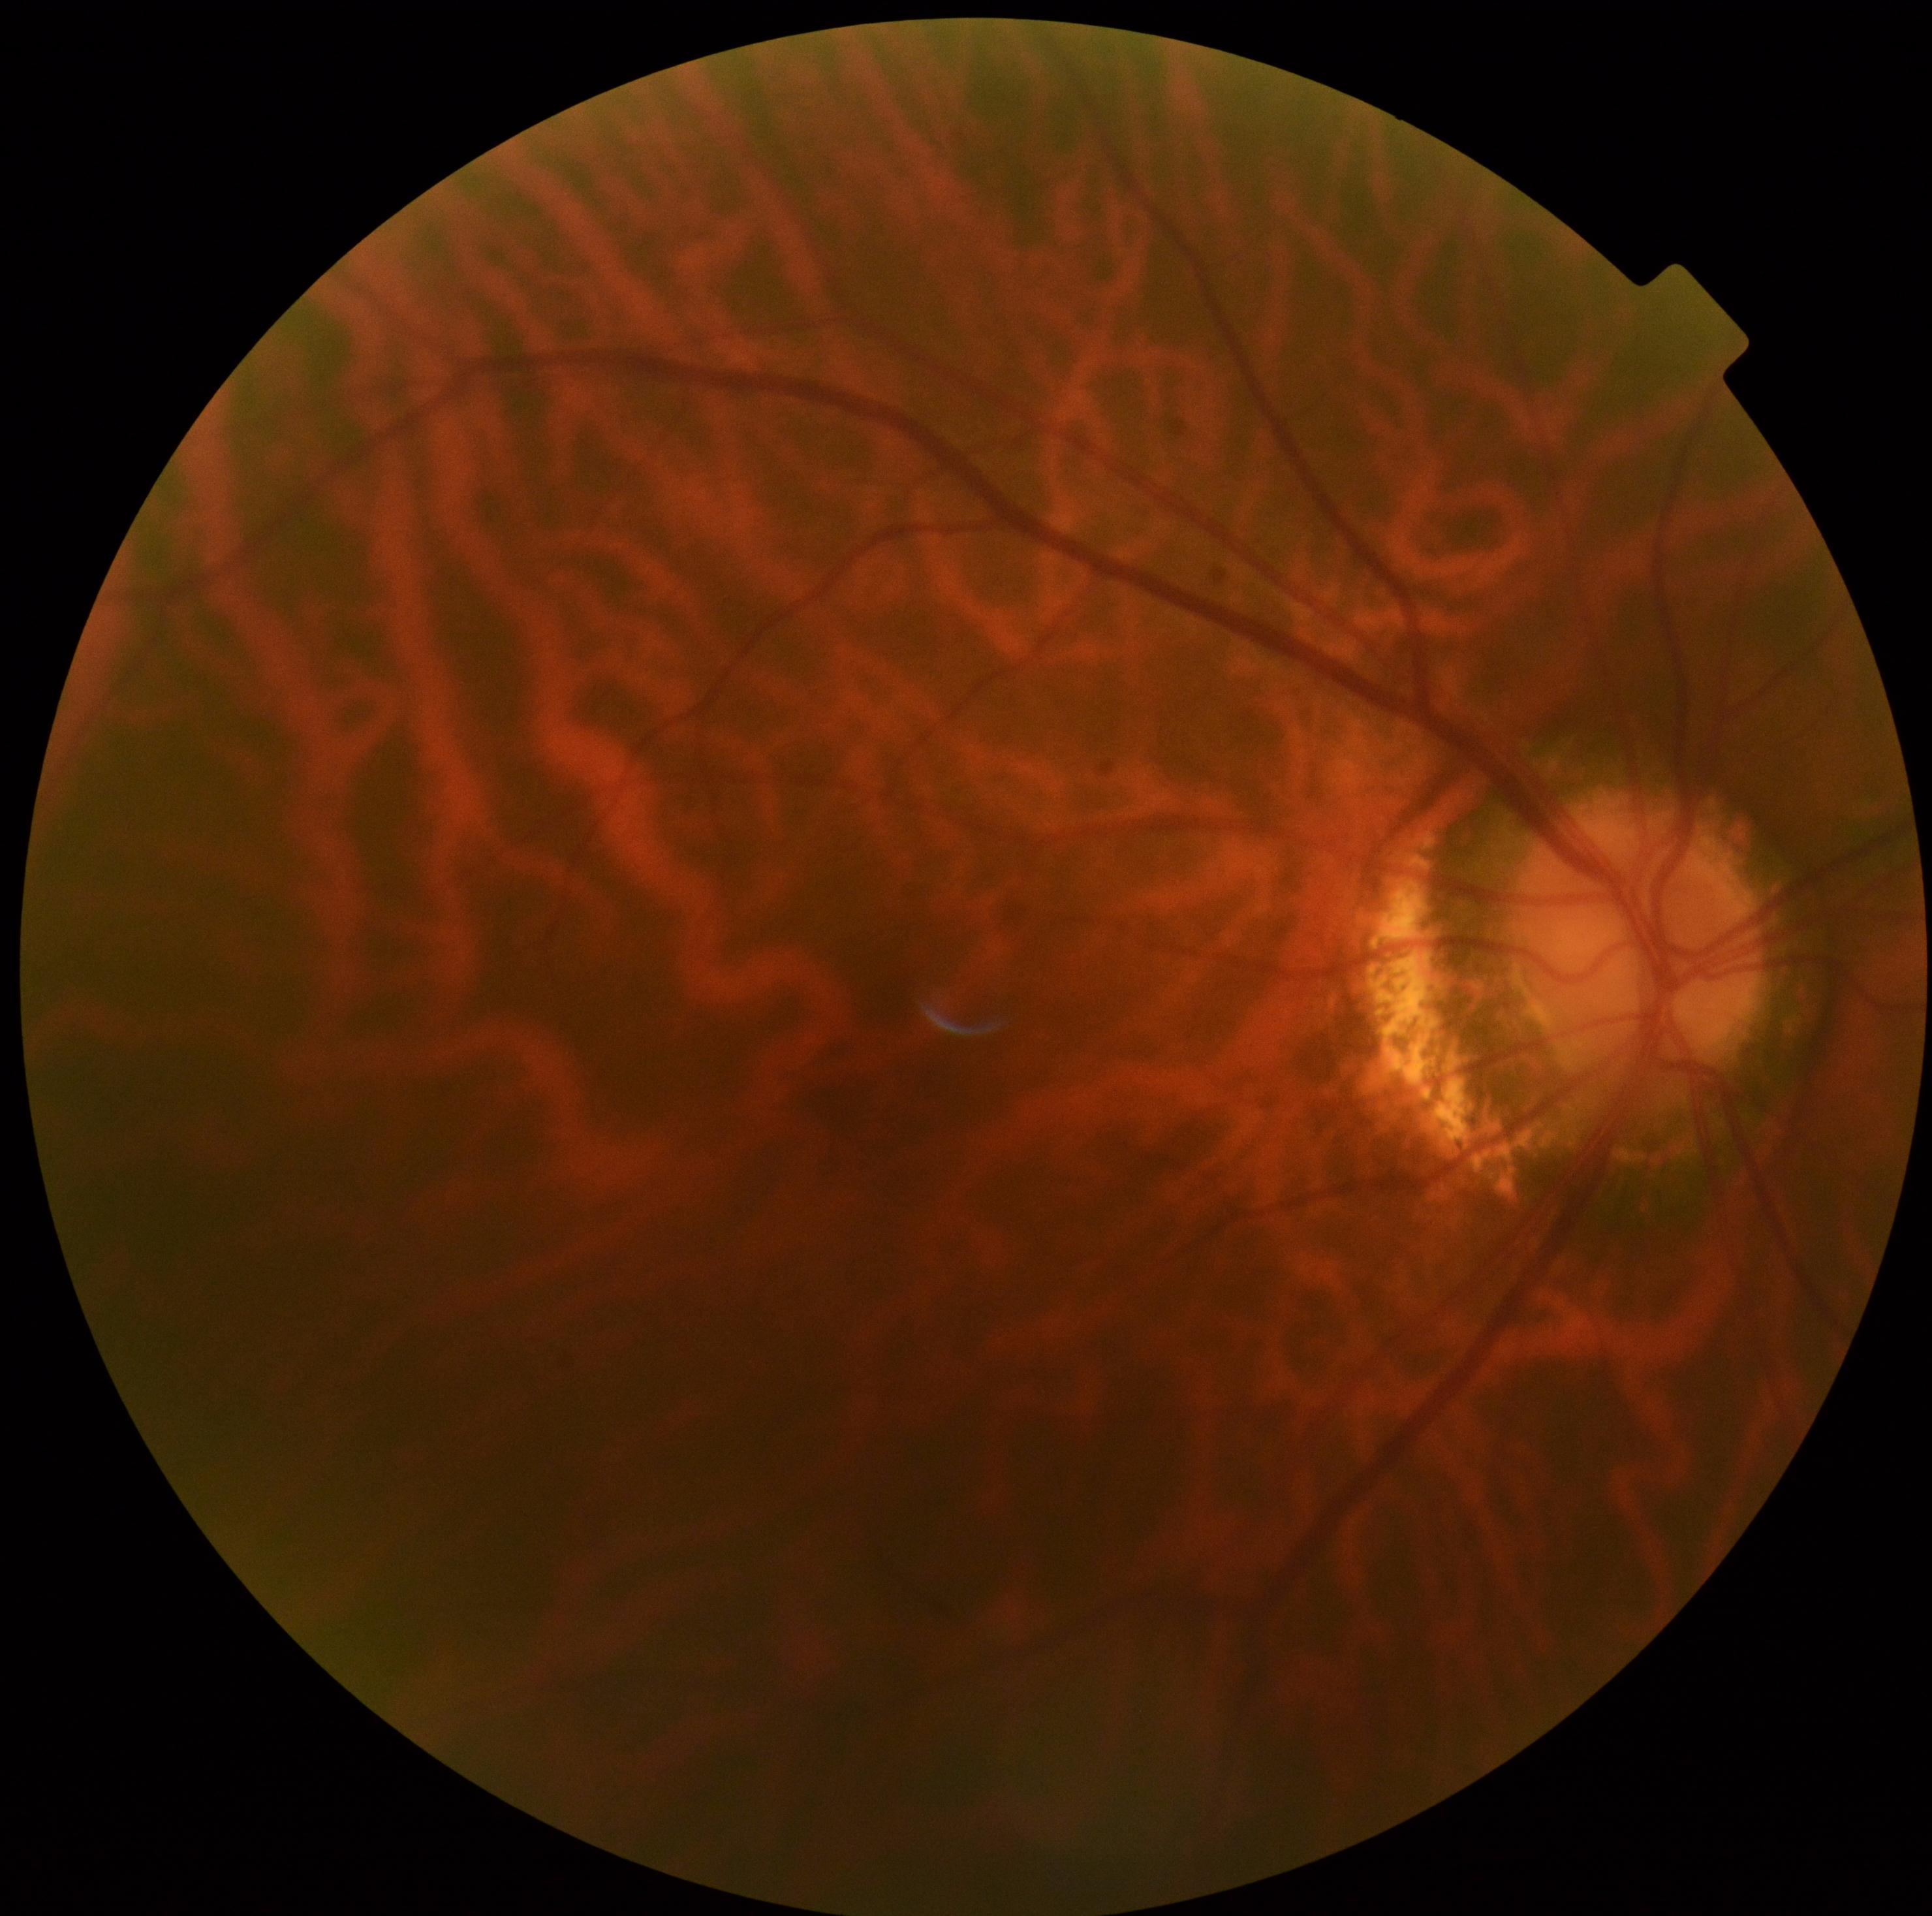   dr_grade: grade 0